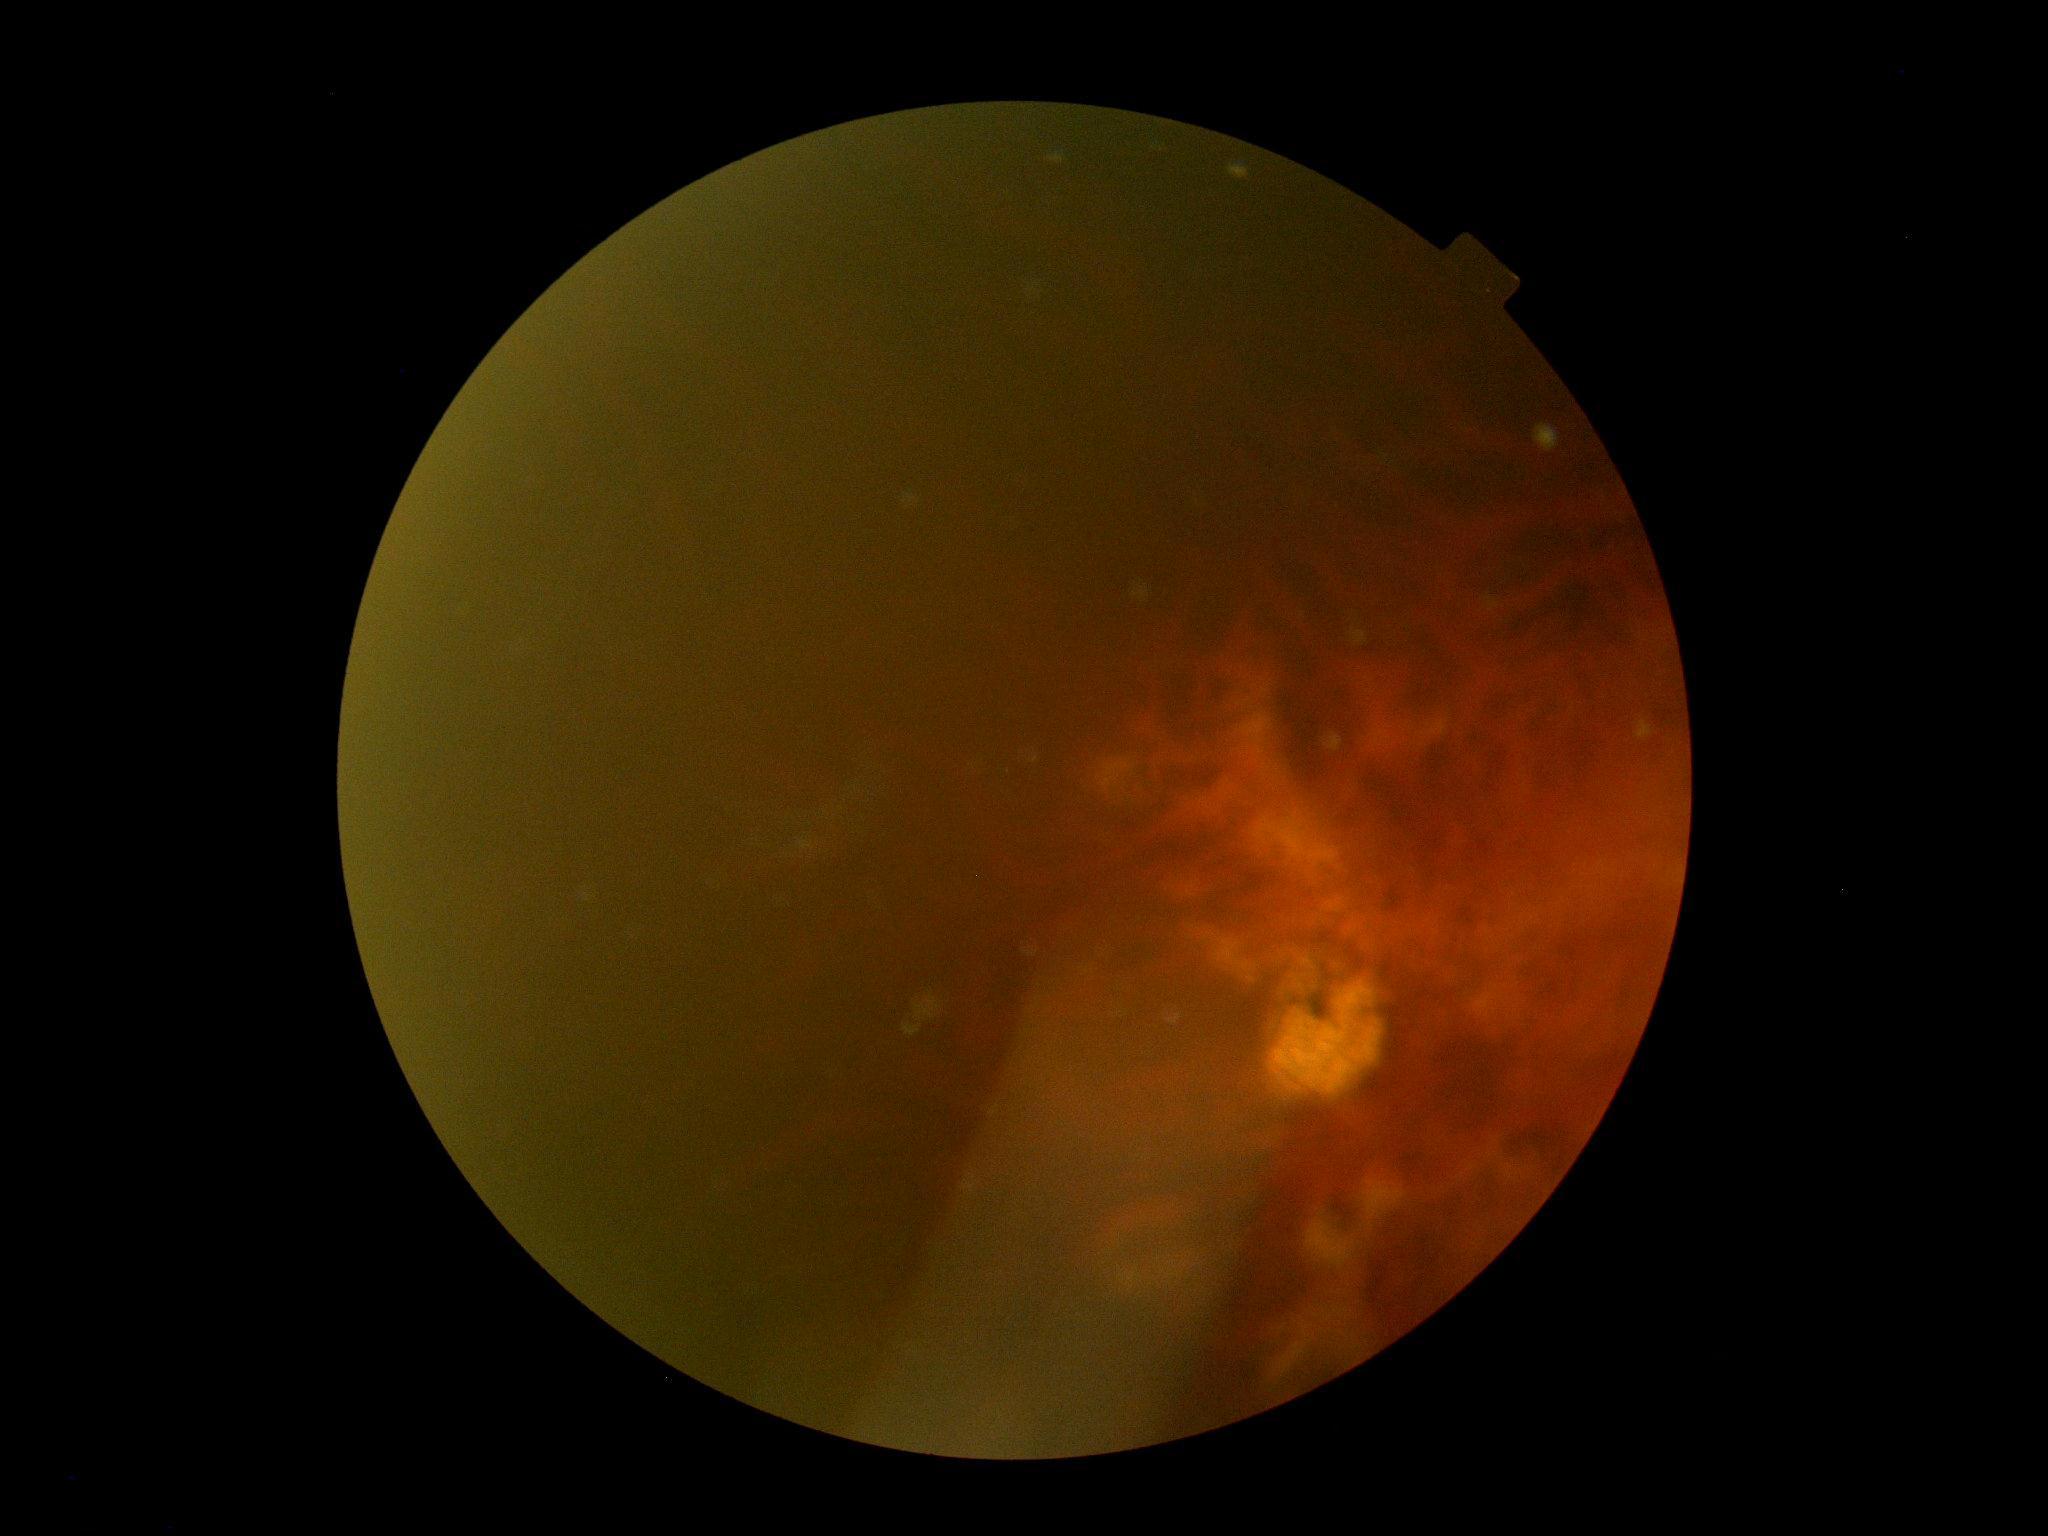

diabetic retinopathy severity=ungradable due to poor image quality.